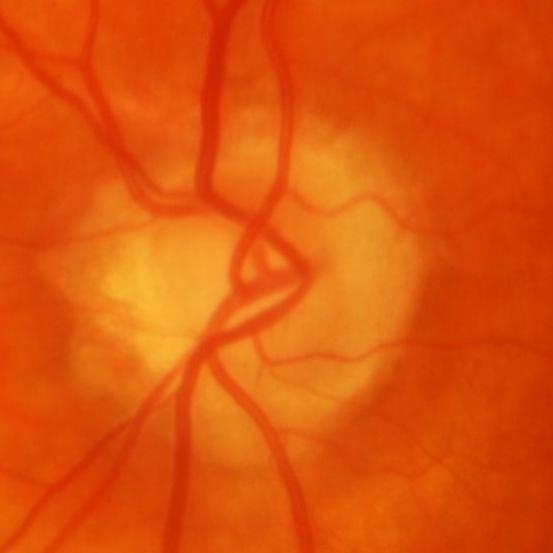

Optic disc photograph showing glaucomatous optic neuropathy.